FOV: 45 degrees. Fundus photo. 2048 by 1536 pixels
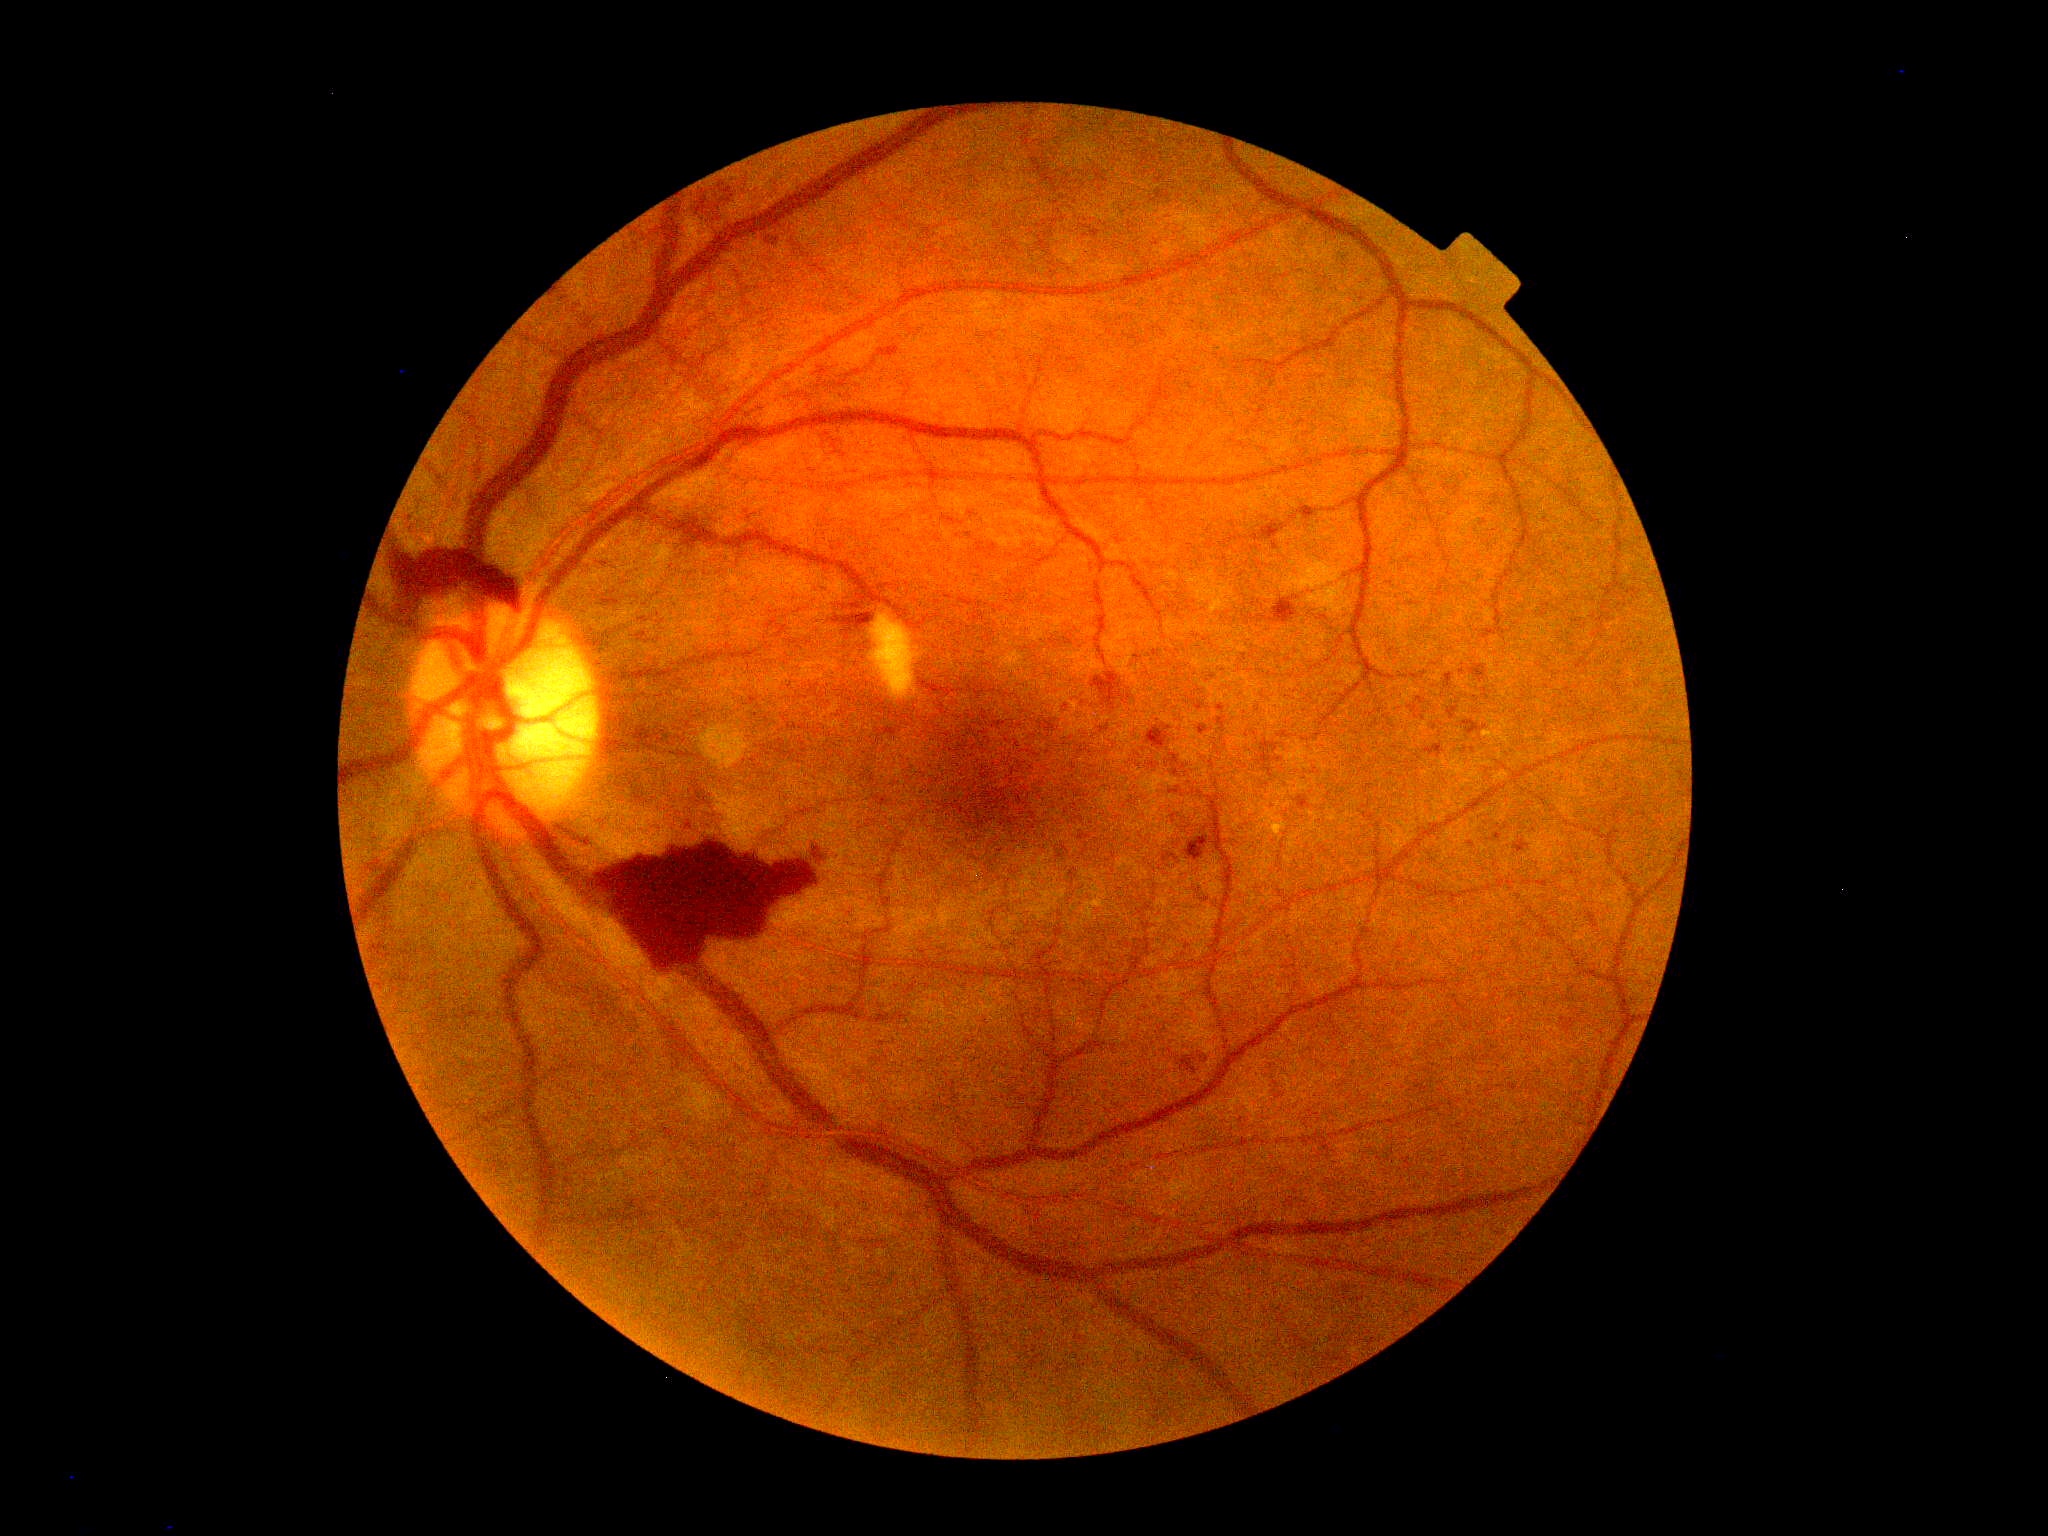 {
  "dr_grade": "4"
}